Color fundus photograph
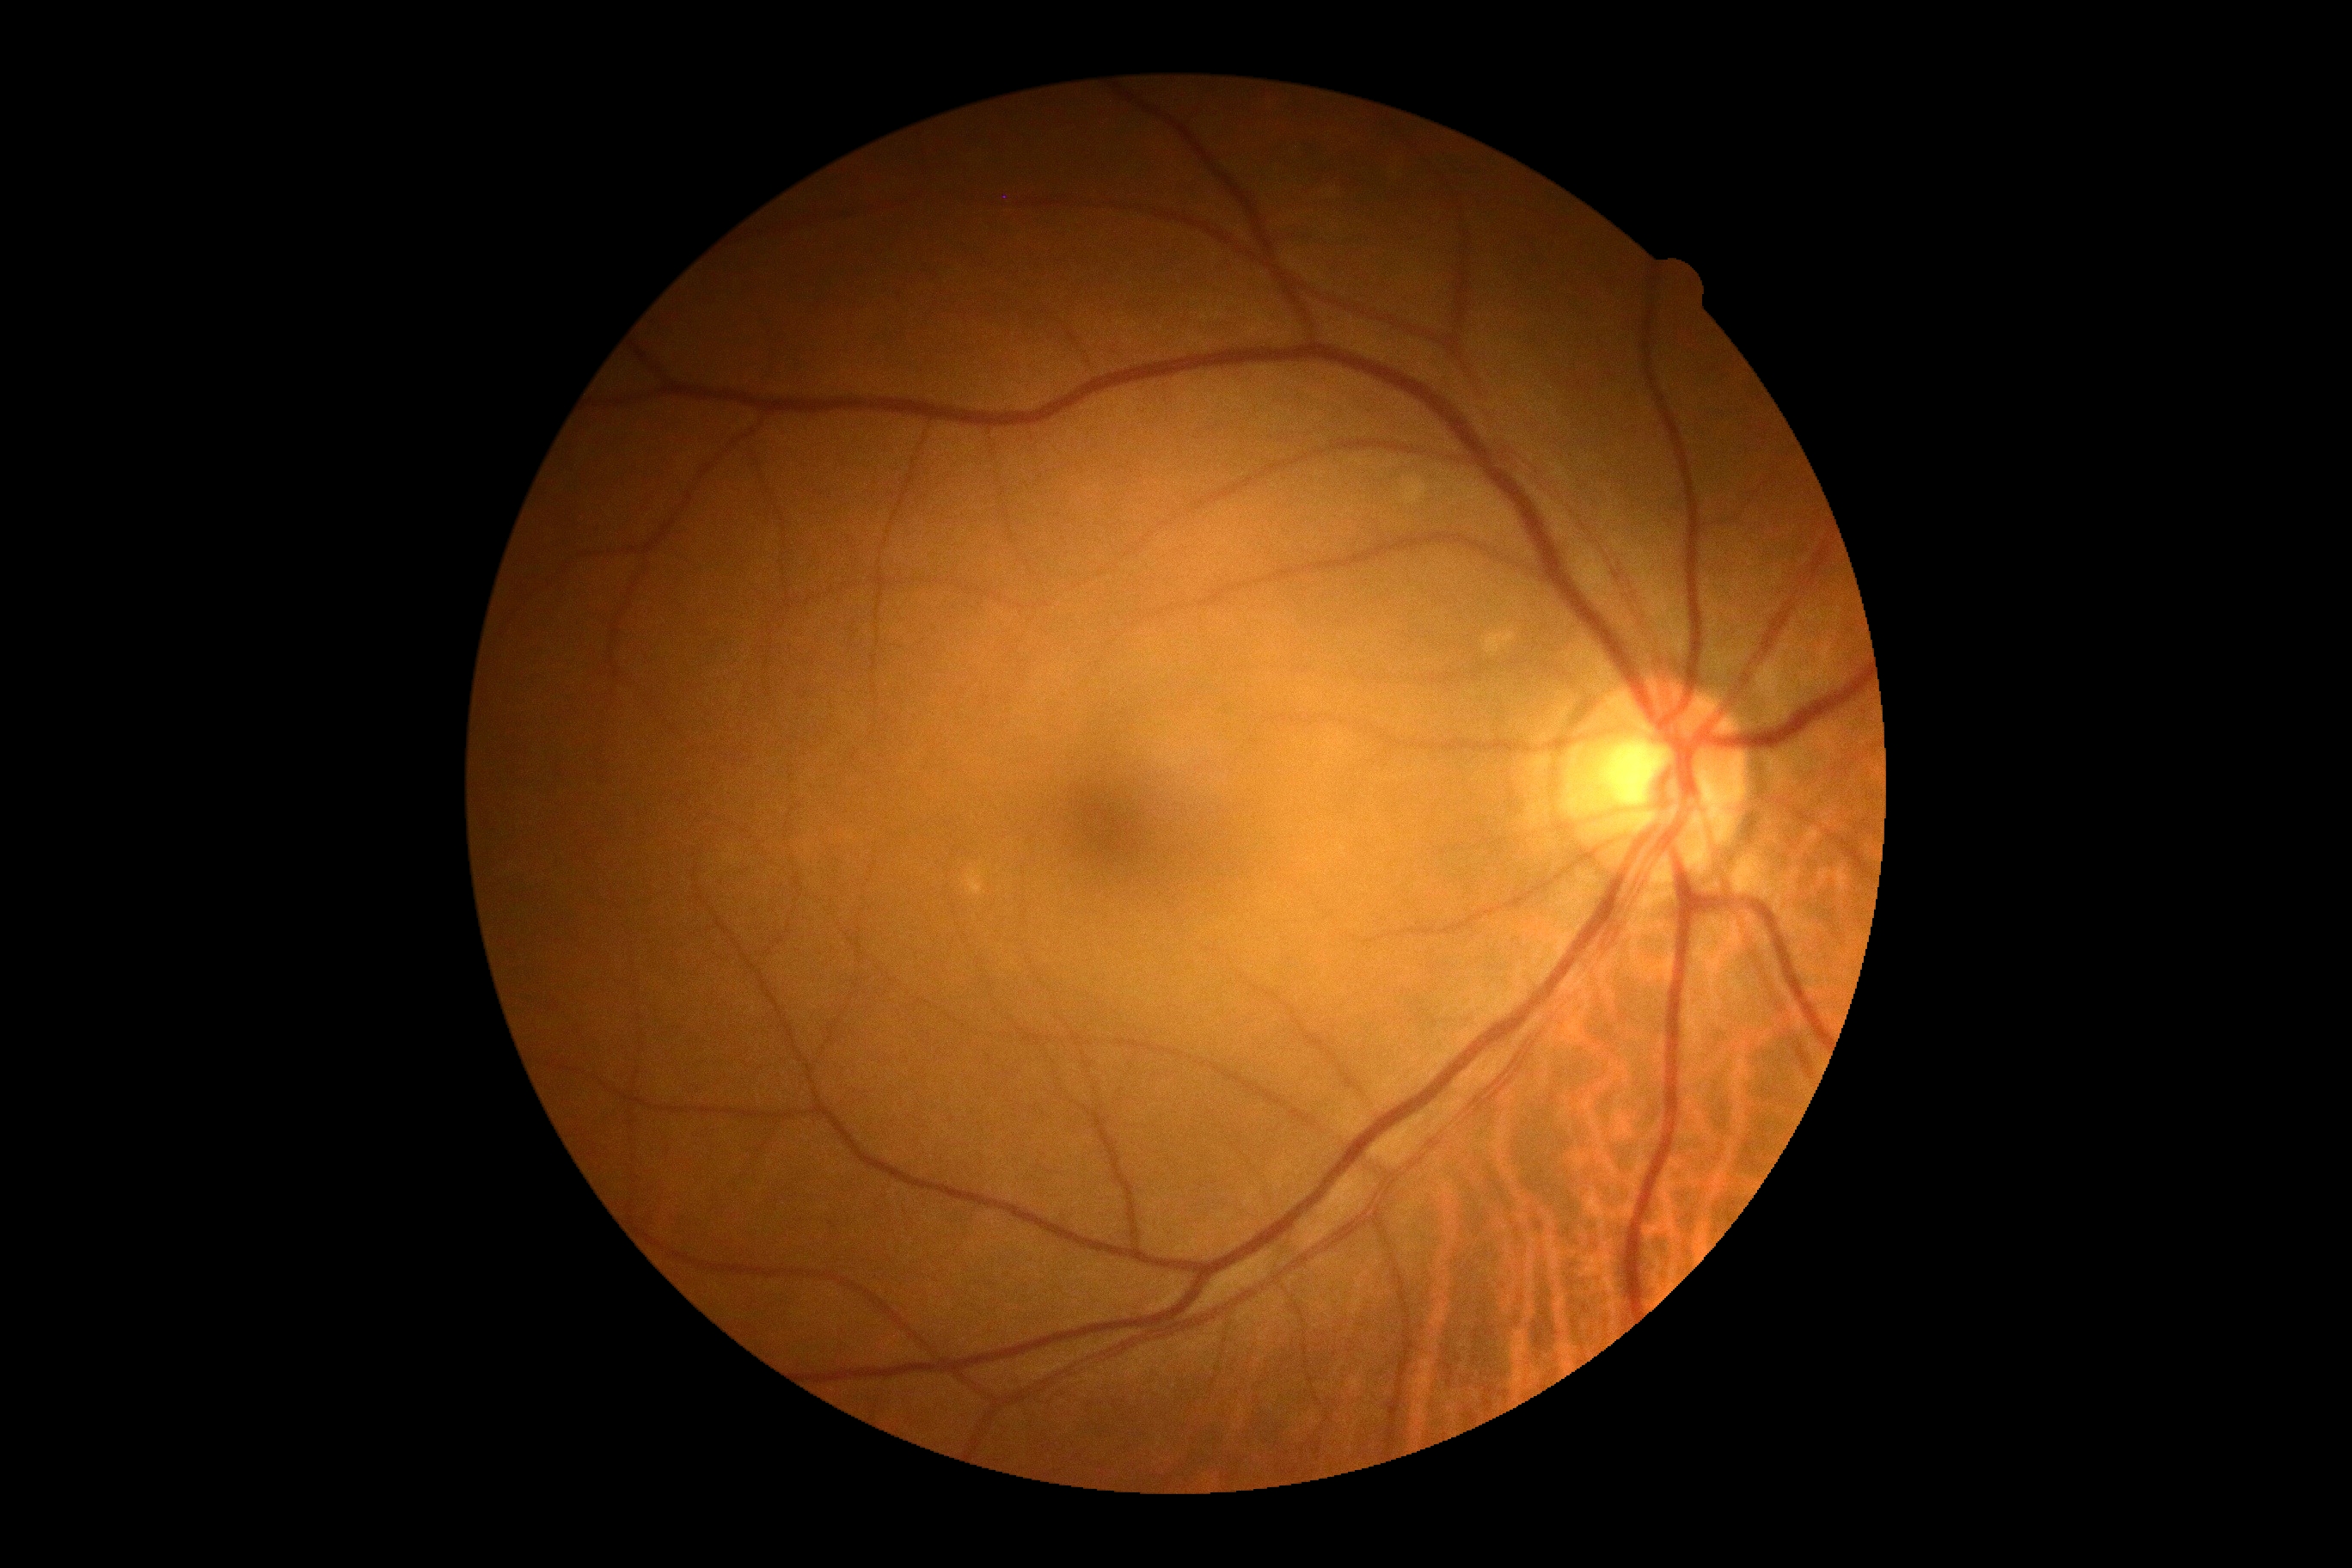
DR: 0/4.